1440 by 1080 pixels · wide-field fundus photograph from neonatal ROP screening
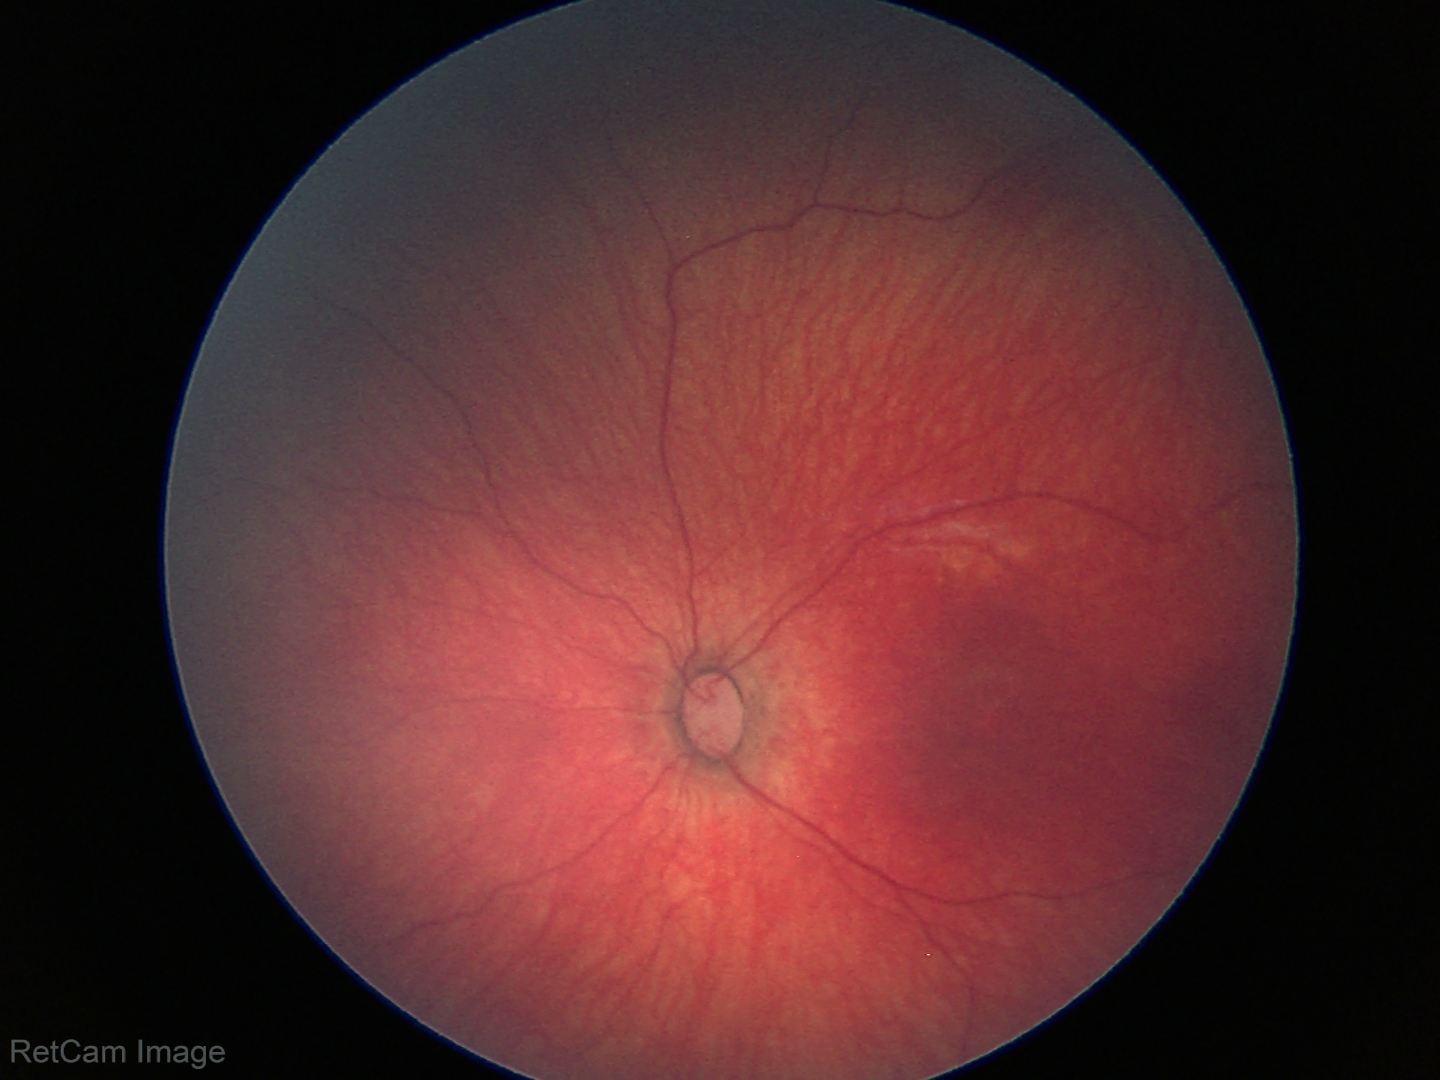

Impression: normal fundus examination.